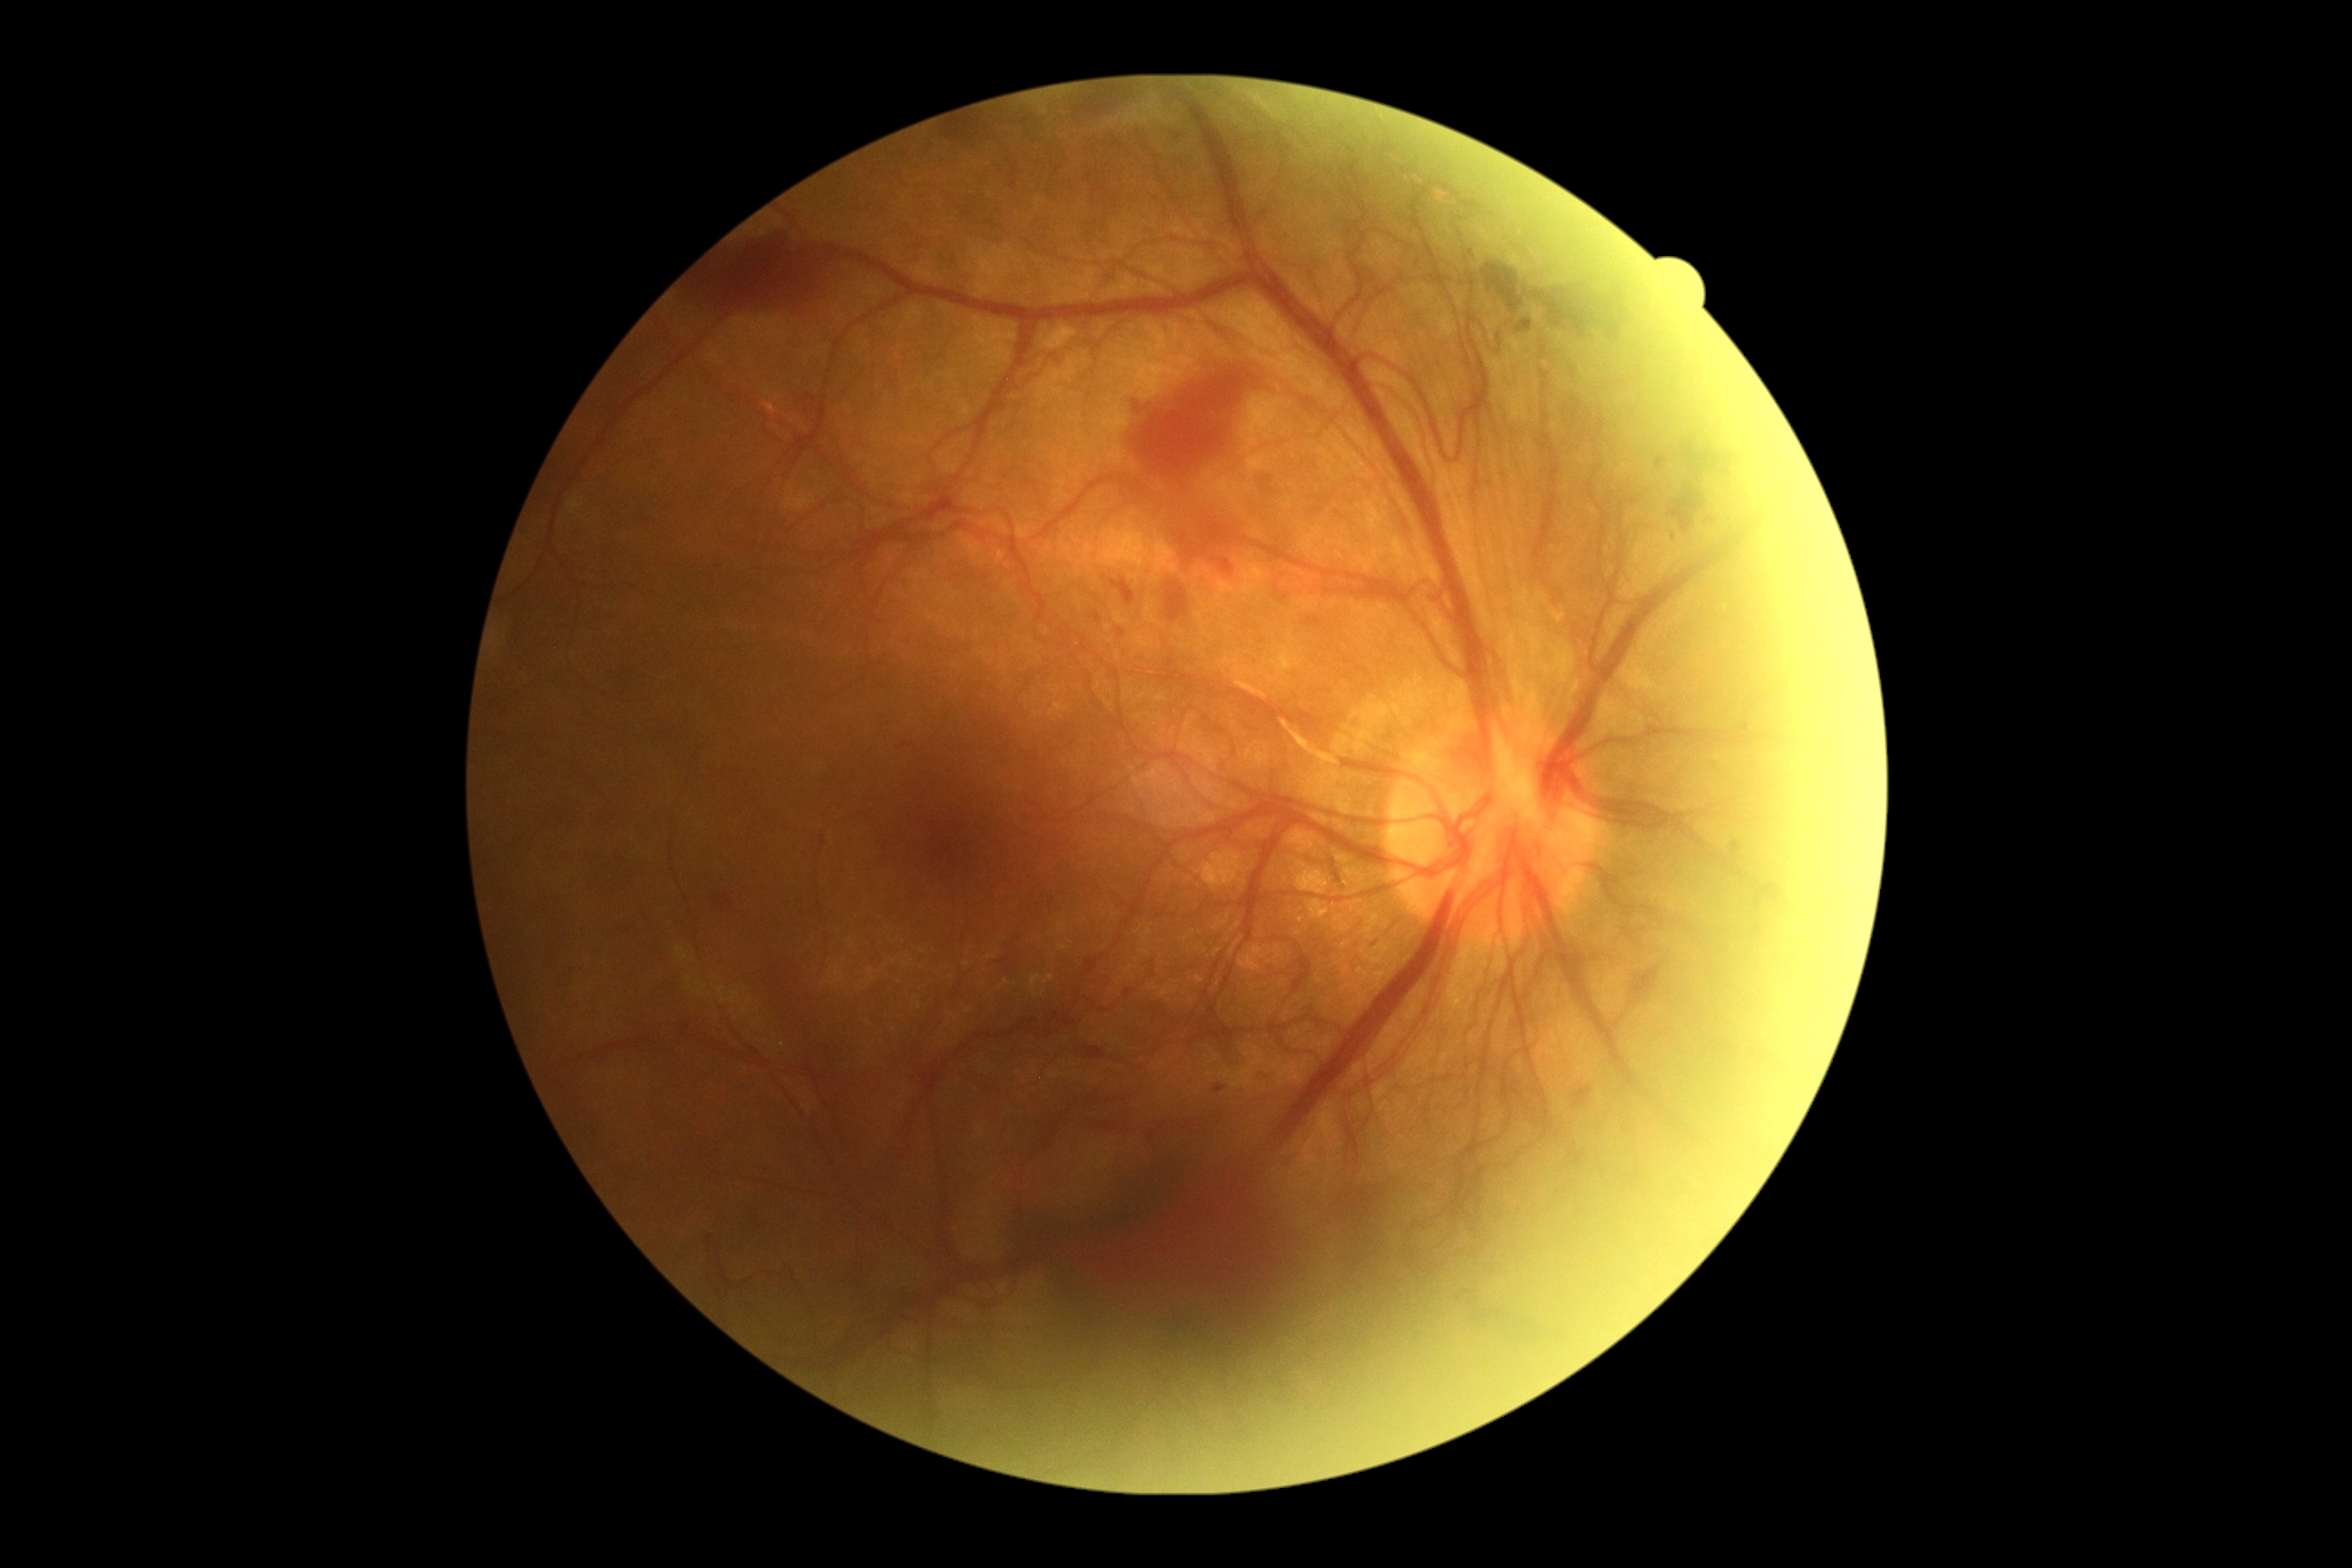
DR grade: 4.